DR severity per modified Davis staging, acquired with a NIDEK AFC-230: 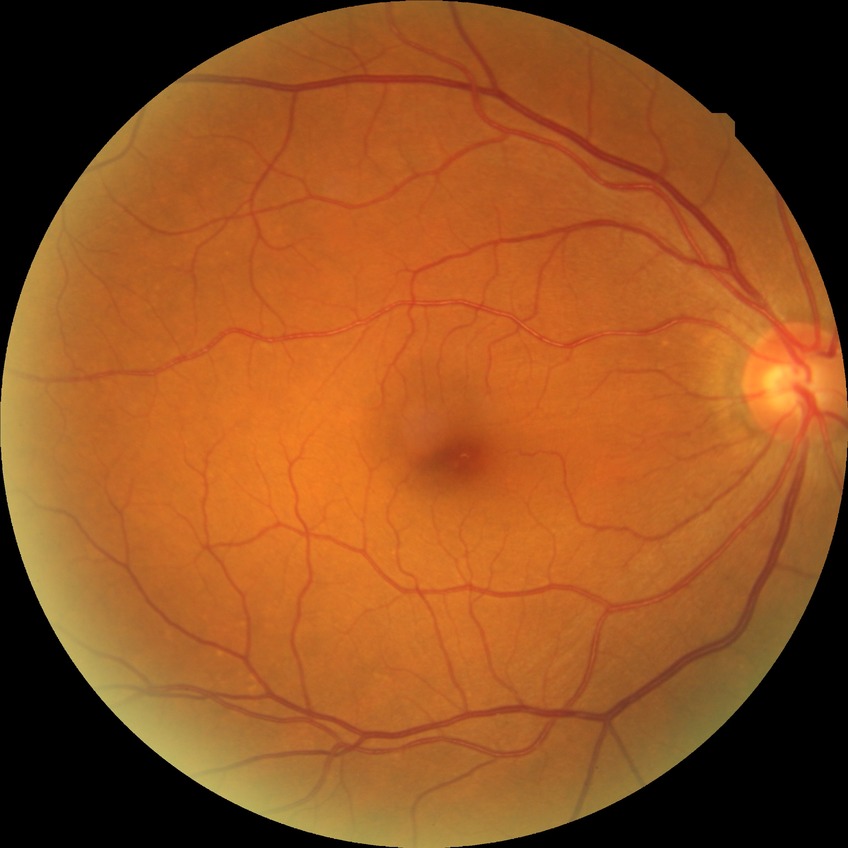 diabetic retinopathy (DR) = no diabetic retinopathy (NDR)